Image size 1932x1932.
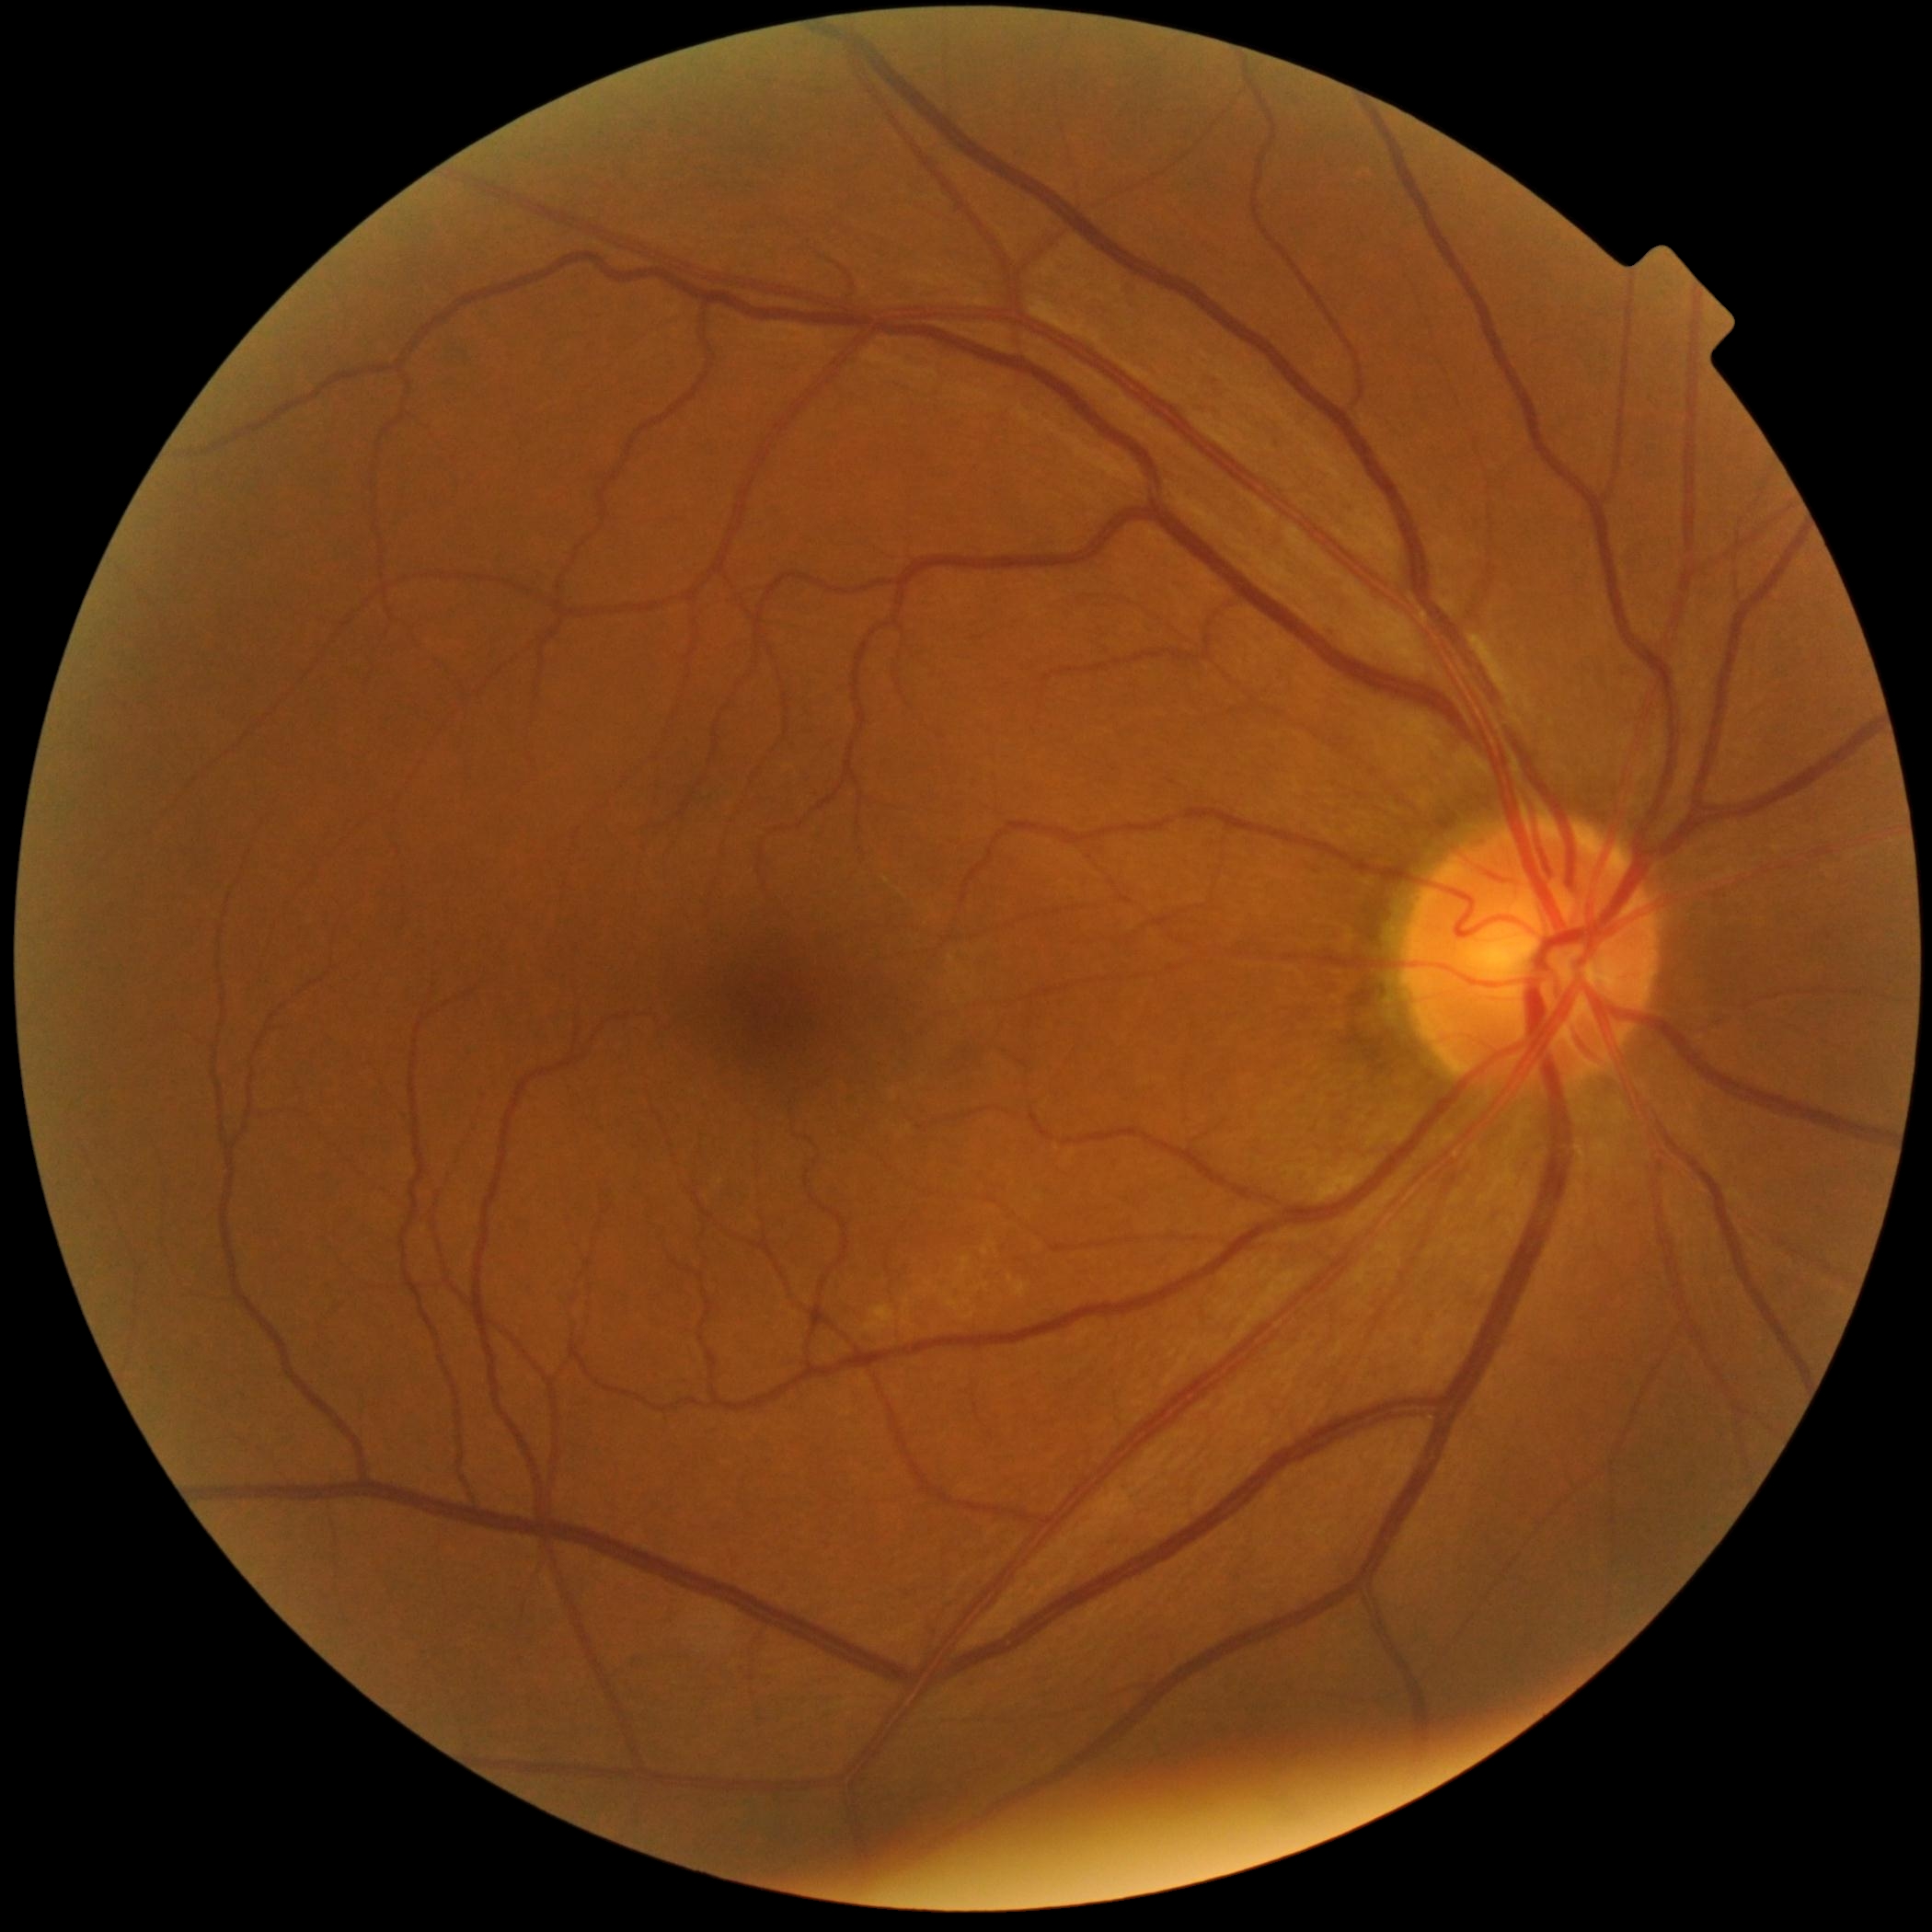

{"dr_grade": "0/4 — no visible signs of diabetic retinopathy", "dr_impression": "no apparent DR"}